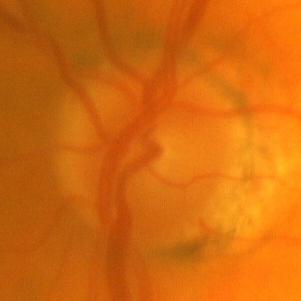
Glaucoma diagnosis: no glaucoma.